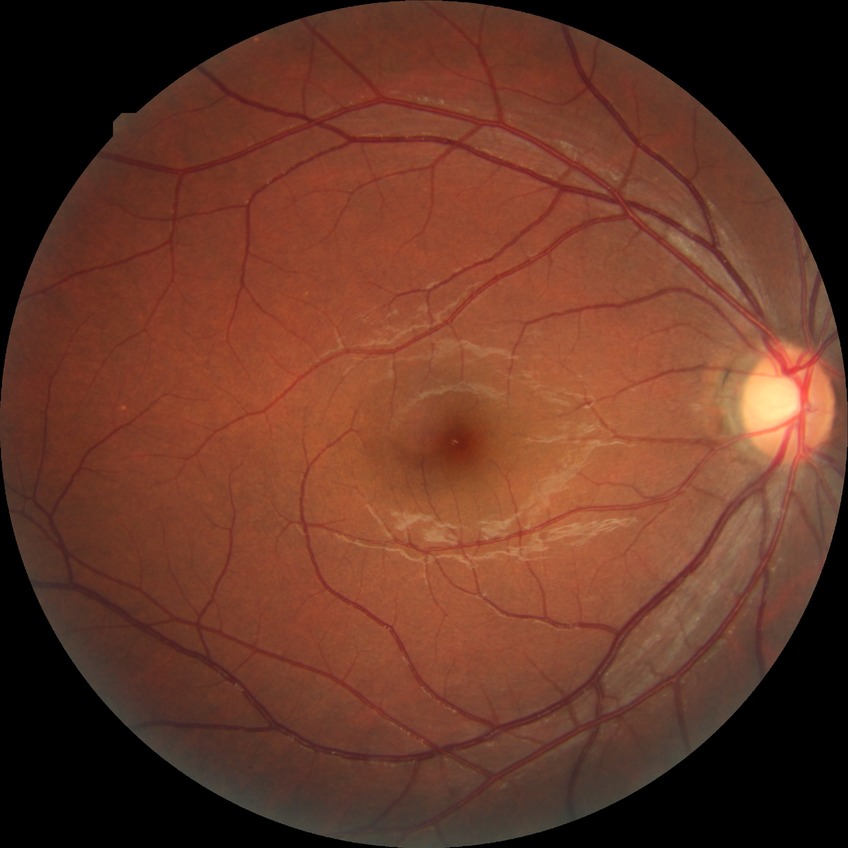

Retinopathy stage: no diabetic retinopathy.